Image size 1932x1916. 45° field of view. Retinal fundus photograph:
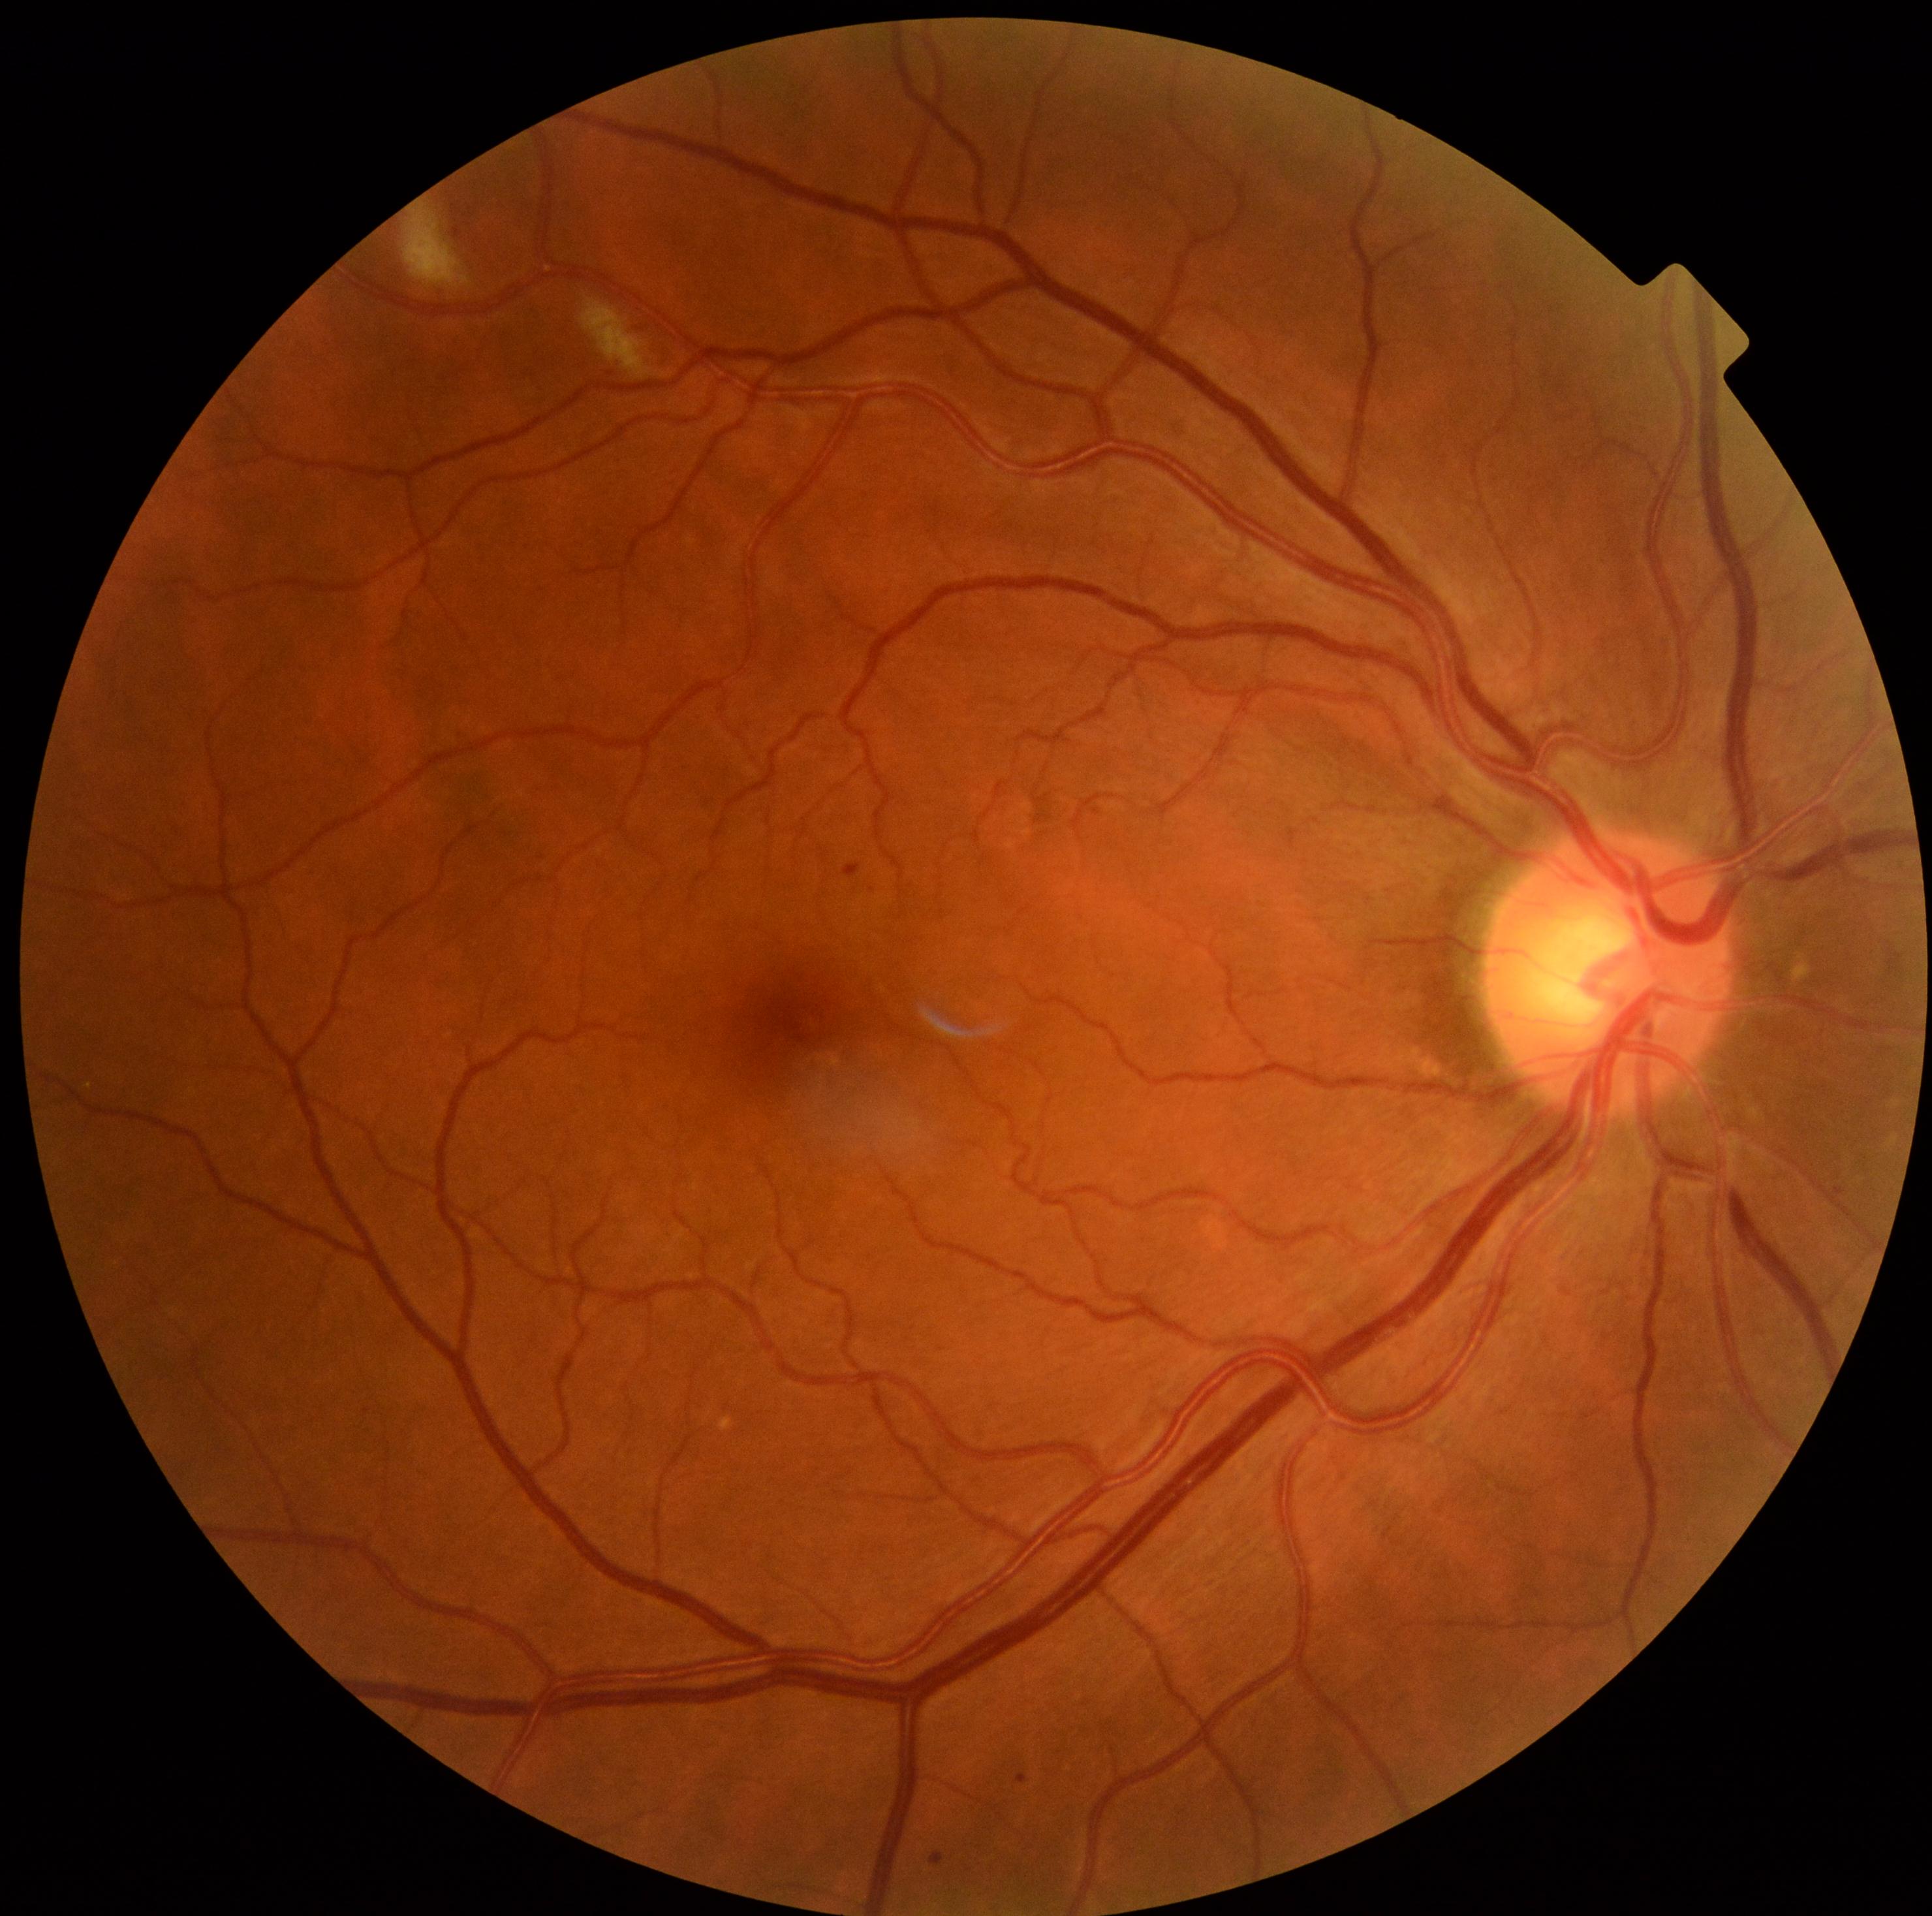

Findings:
* diabetic retinopathy (DR) — moderate NPDR (grade 2)